Optic nerve head crop, 240 by 240 pixels — 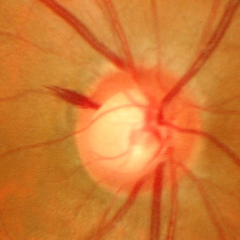 This fundus photograph shows severe glaucomatous damage.